Color fundus image: 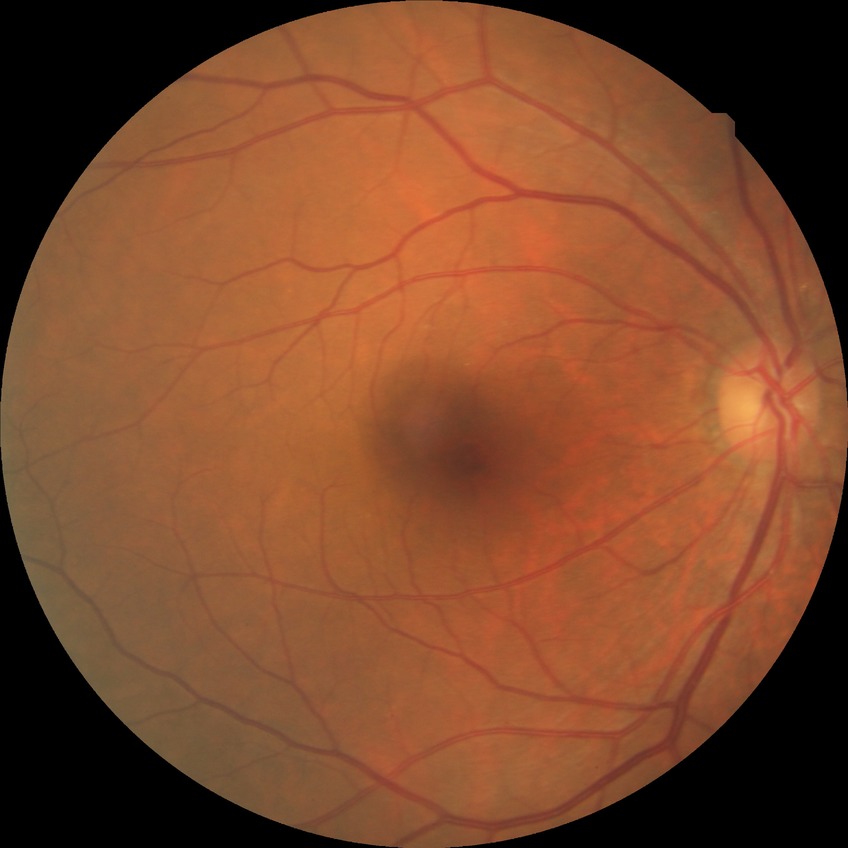
  davis_grade: NDR
  dr_impression: no apparent DR